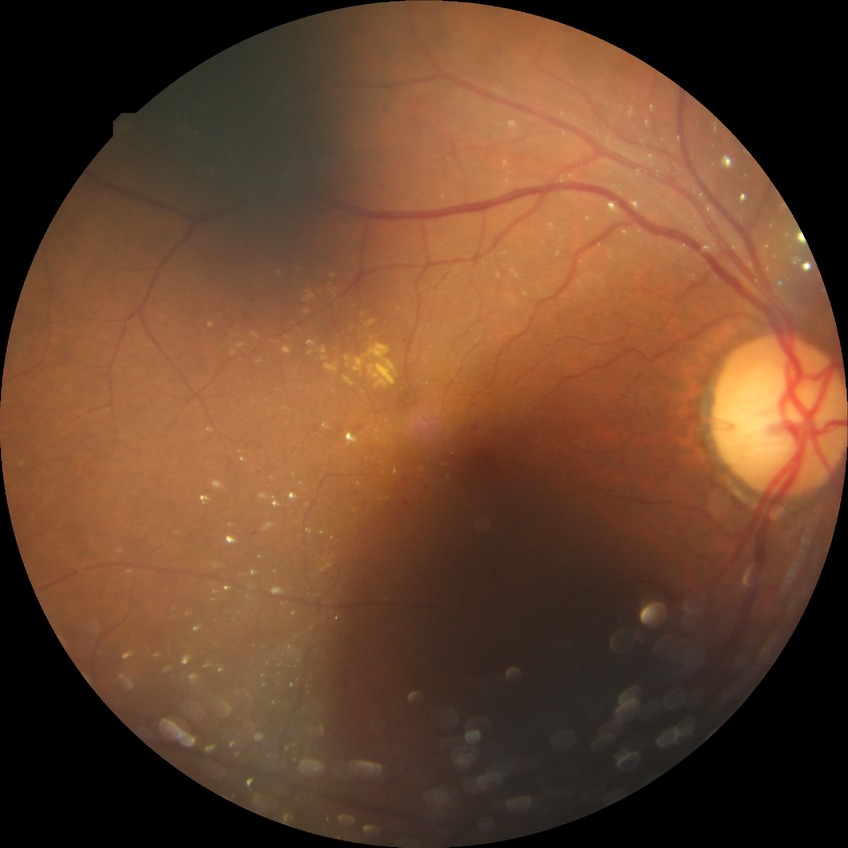
Diabetic retinopathy (DR): SDR (simple diabetic retinopathy).
The retinopathy is classified as non-proliferative diabetic retinopathy.